CFP.
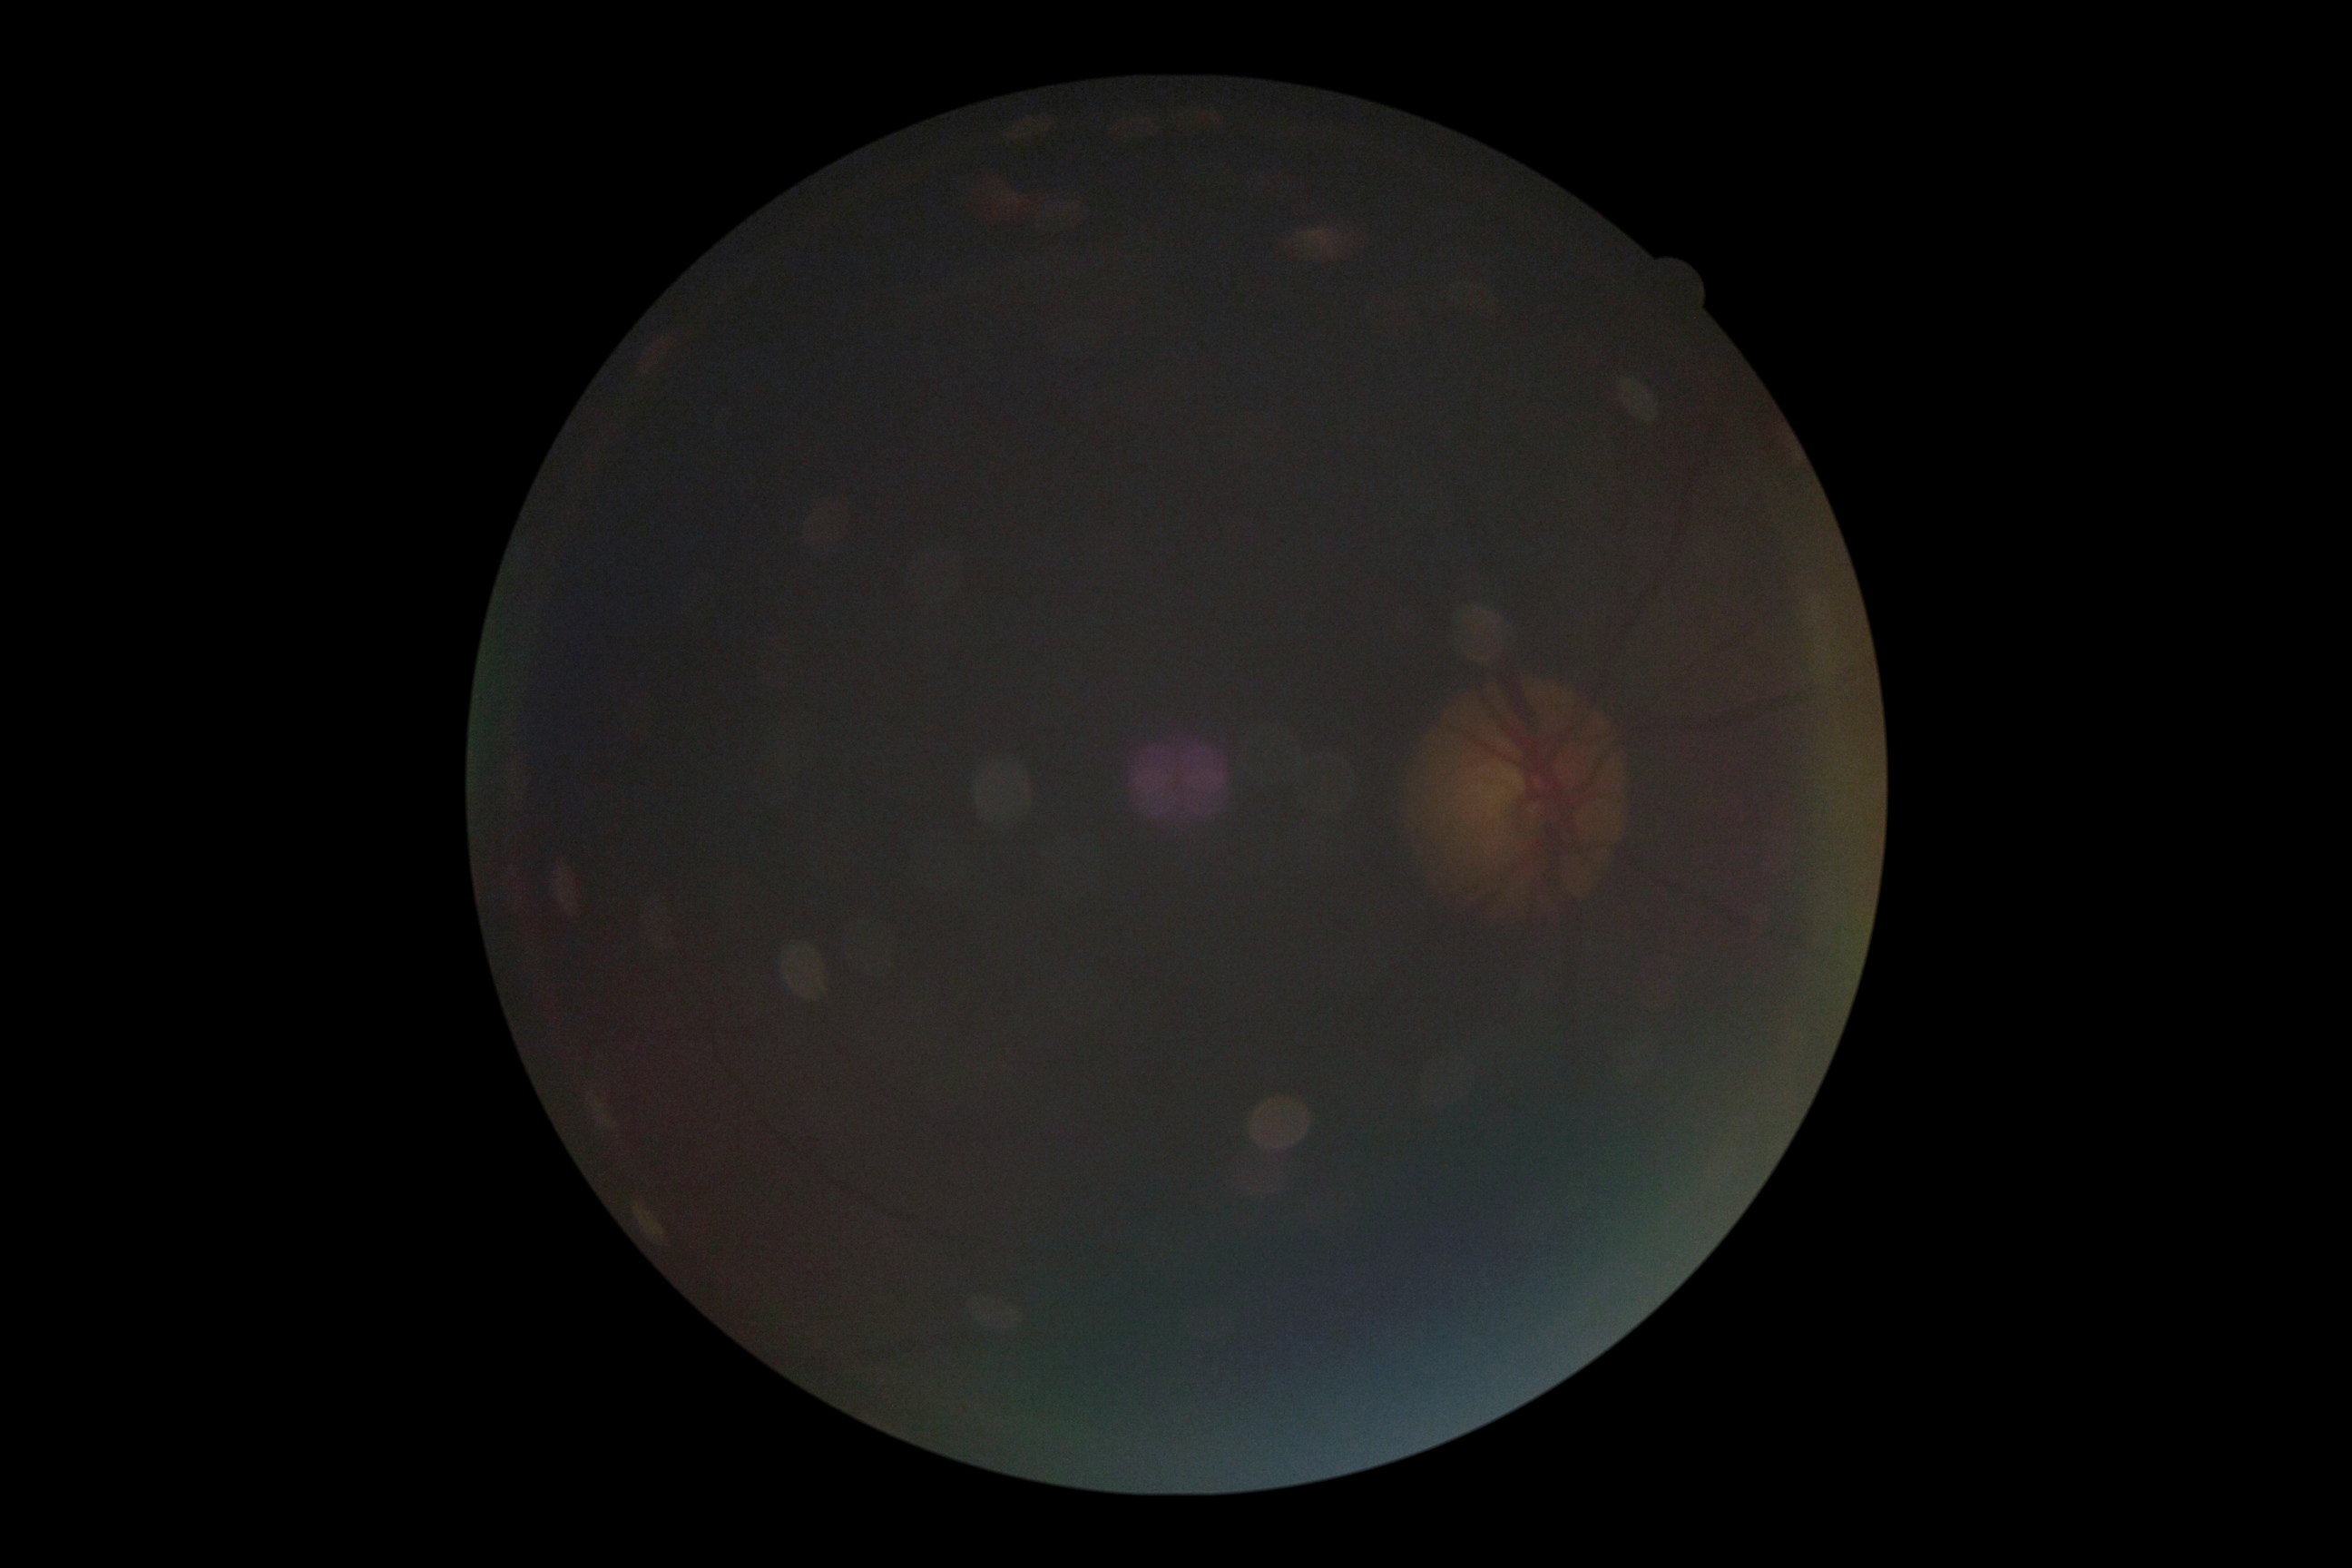

DR grade@ungradable.